Retinal fundus photograph — 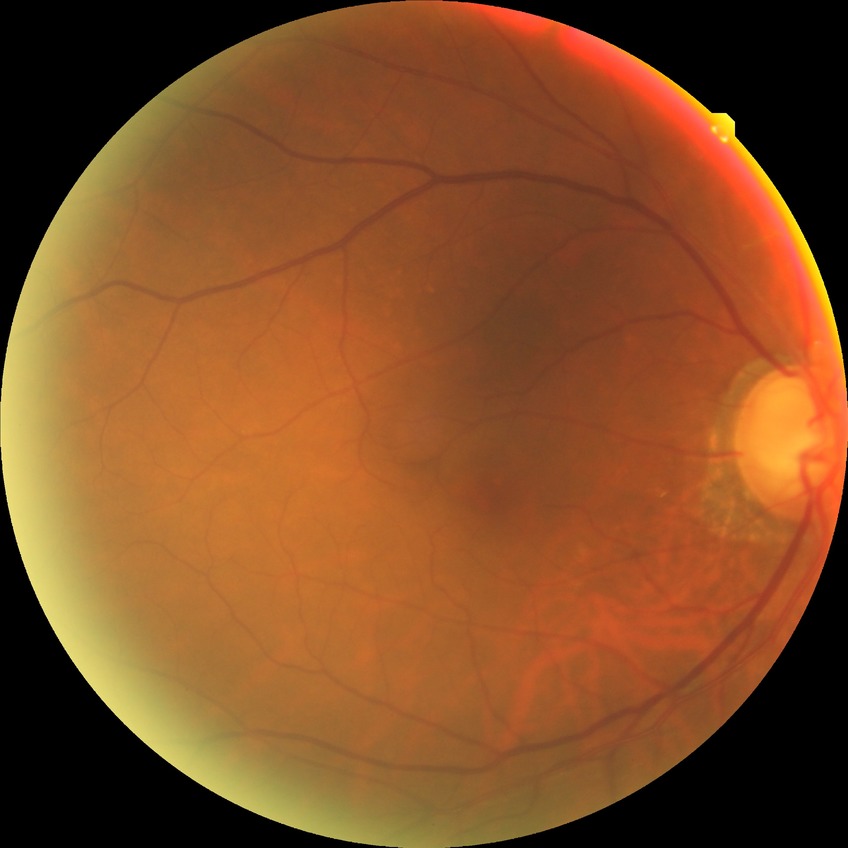 Diabetic retinopathy (DR) is no diabetic retinopathy (NDR).